Color fundus image: 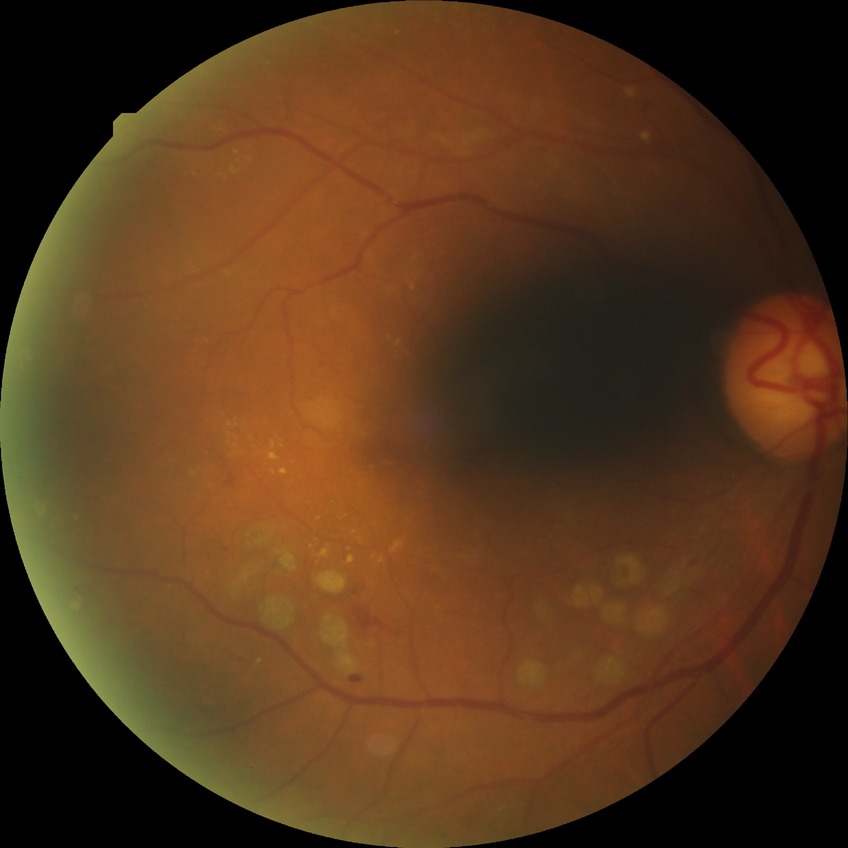

{"davis_grade": "proliferative diabetic retinopathy"}